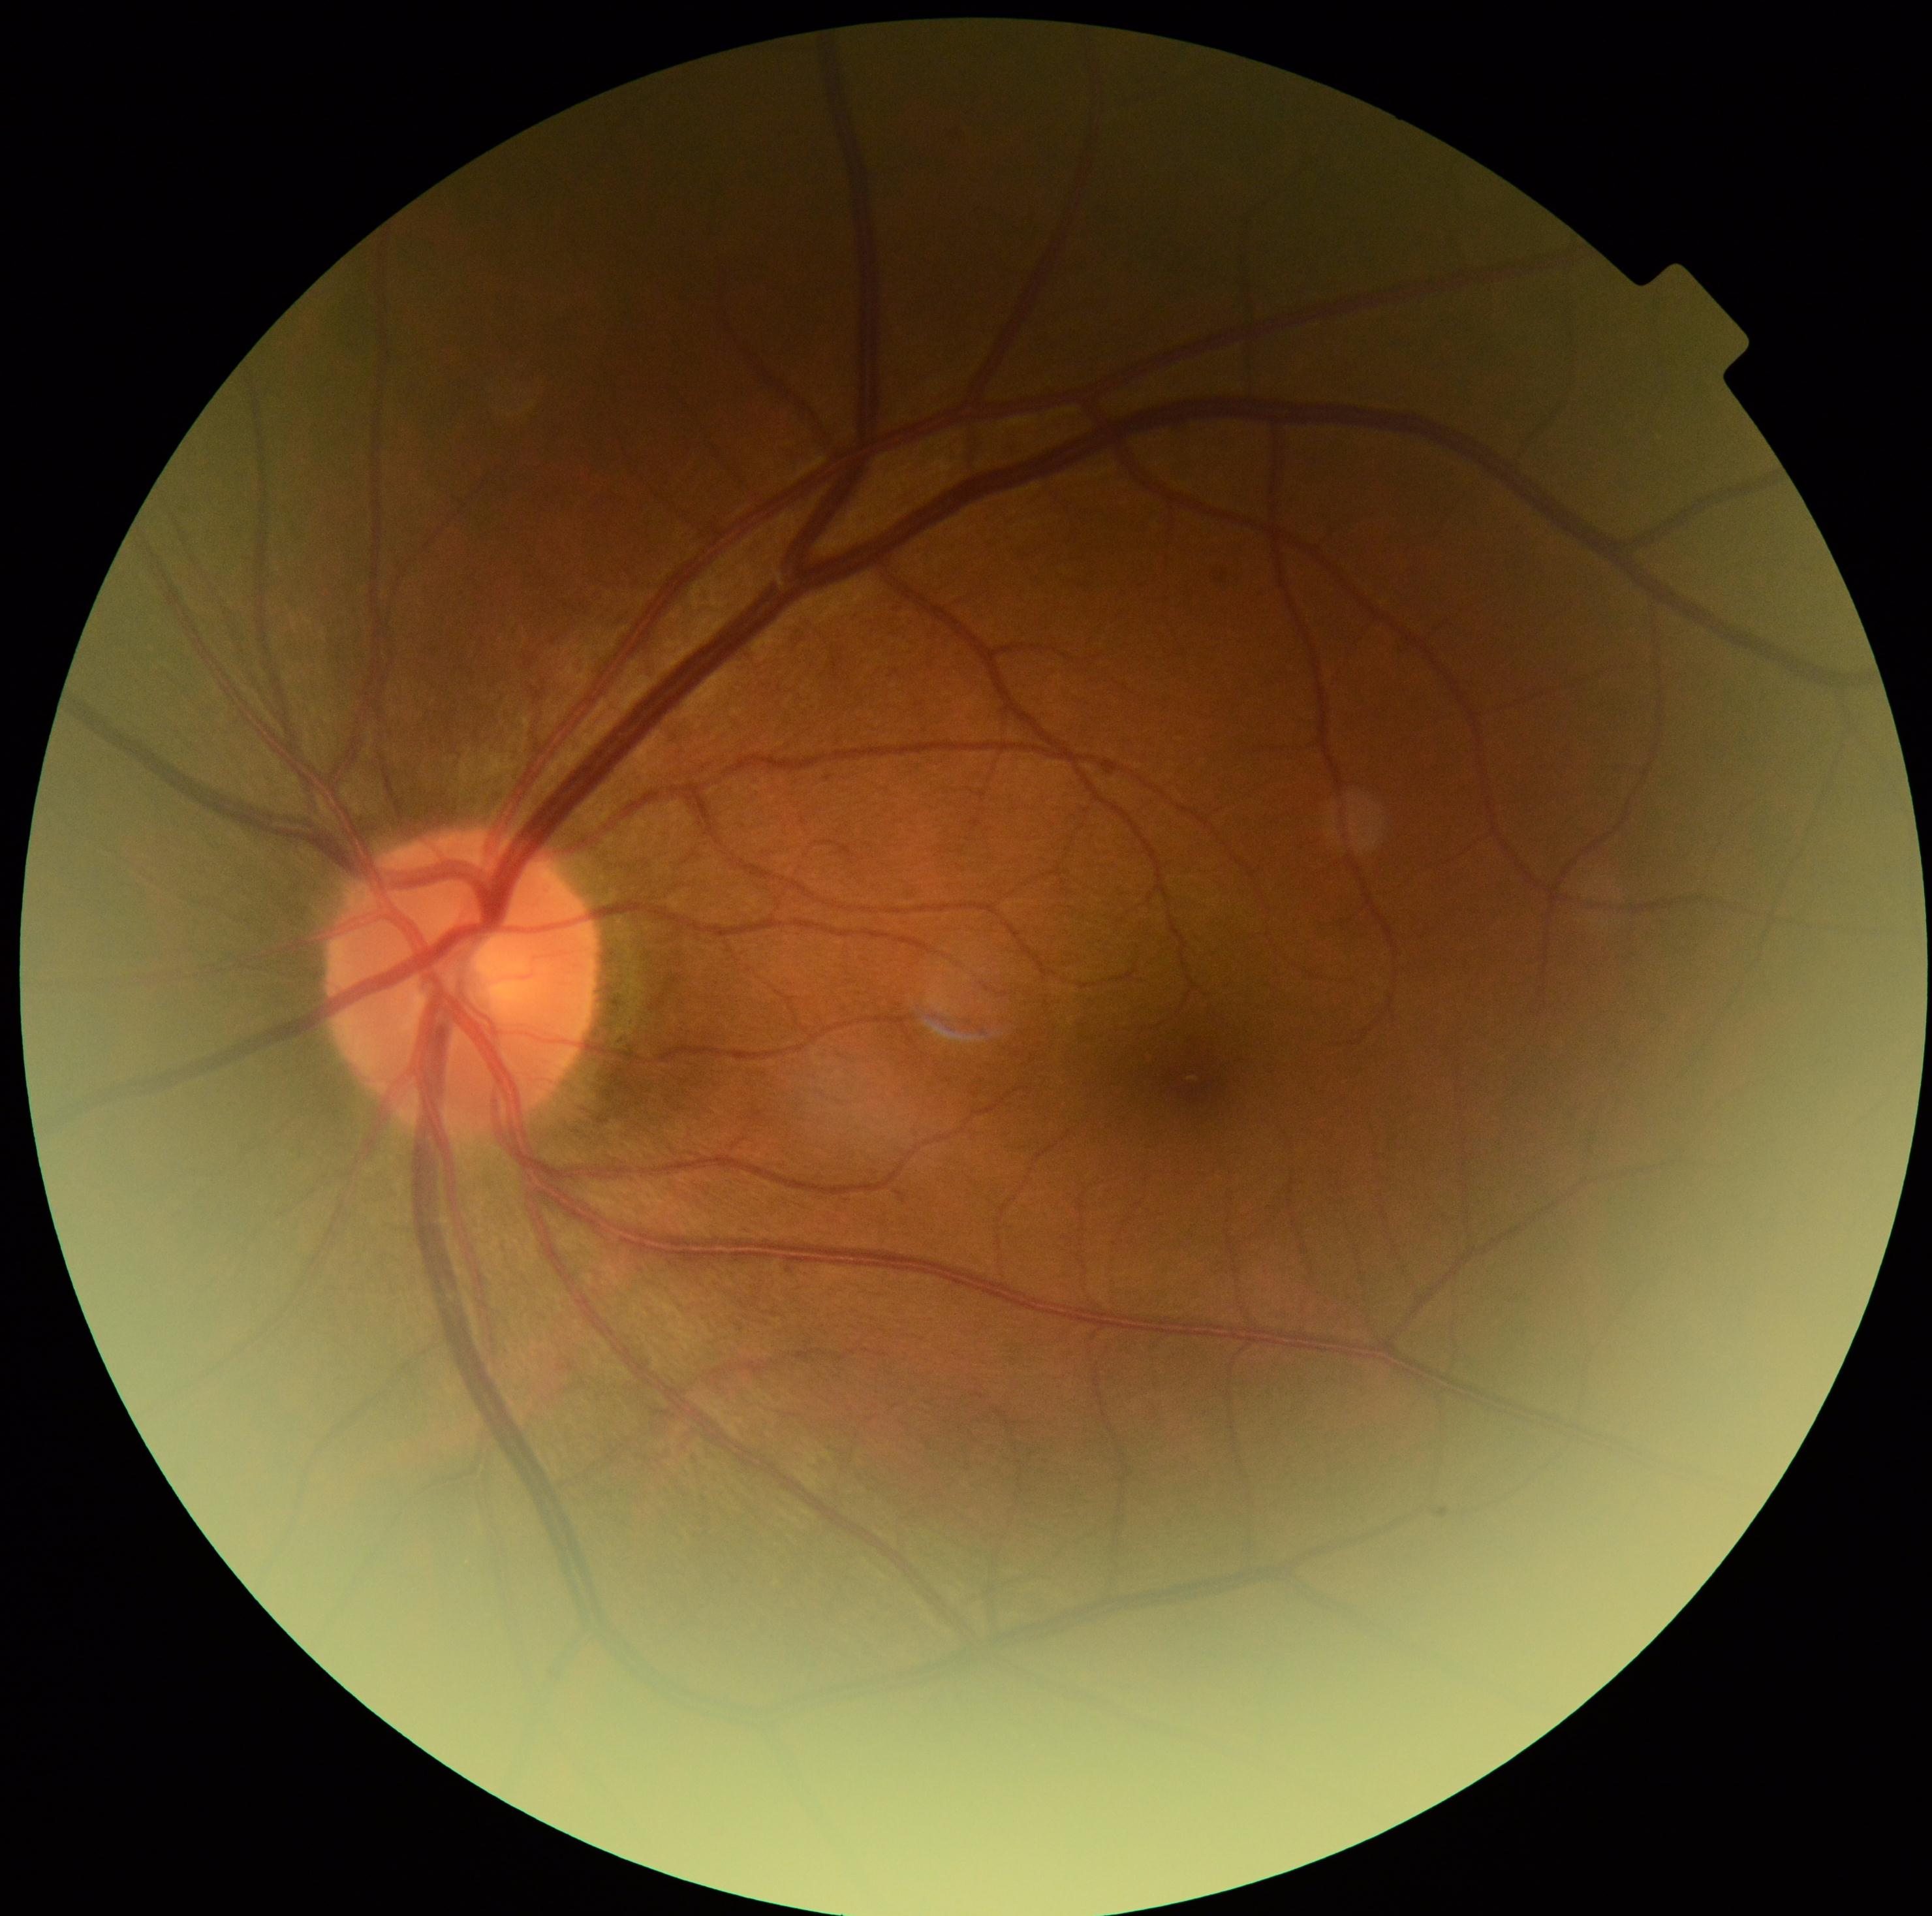

- retinopathy grade — 0 (no apparent retinopathy)